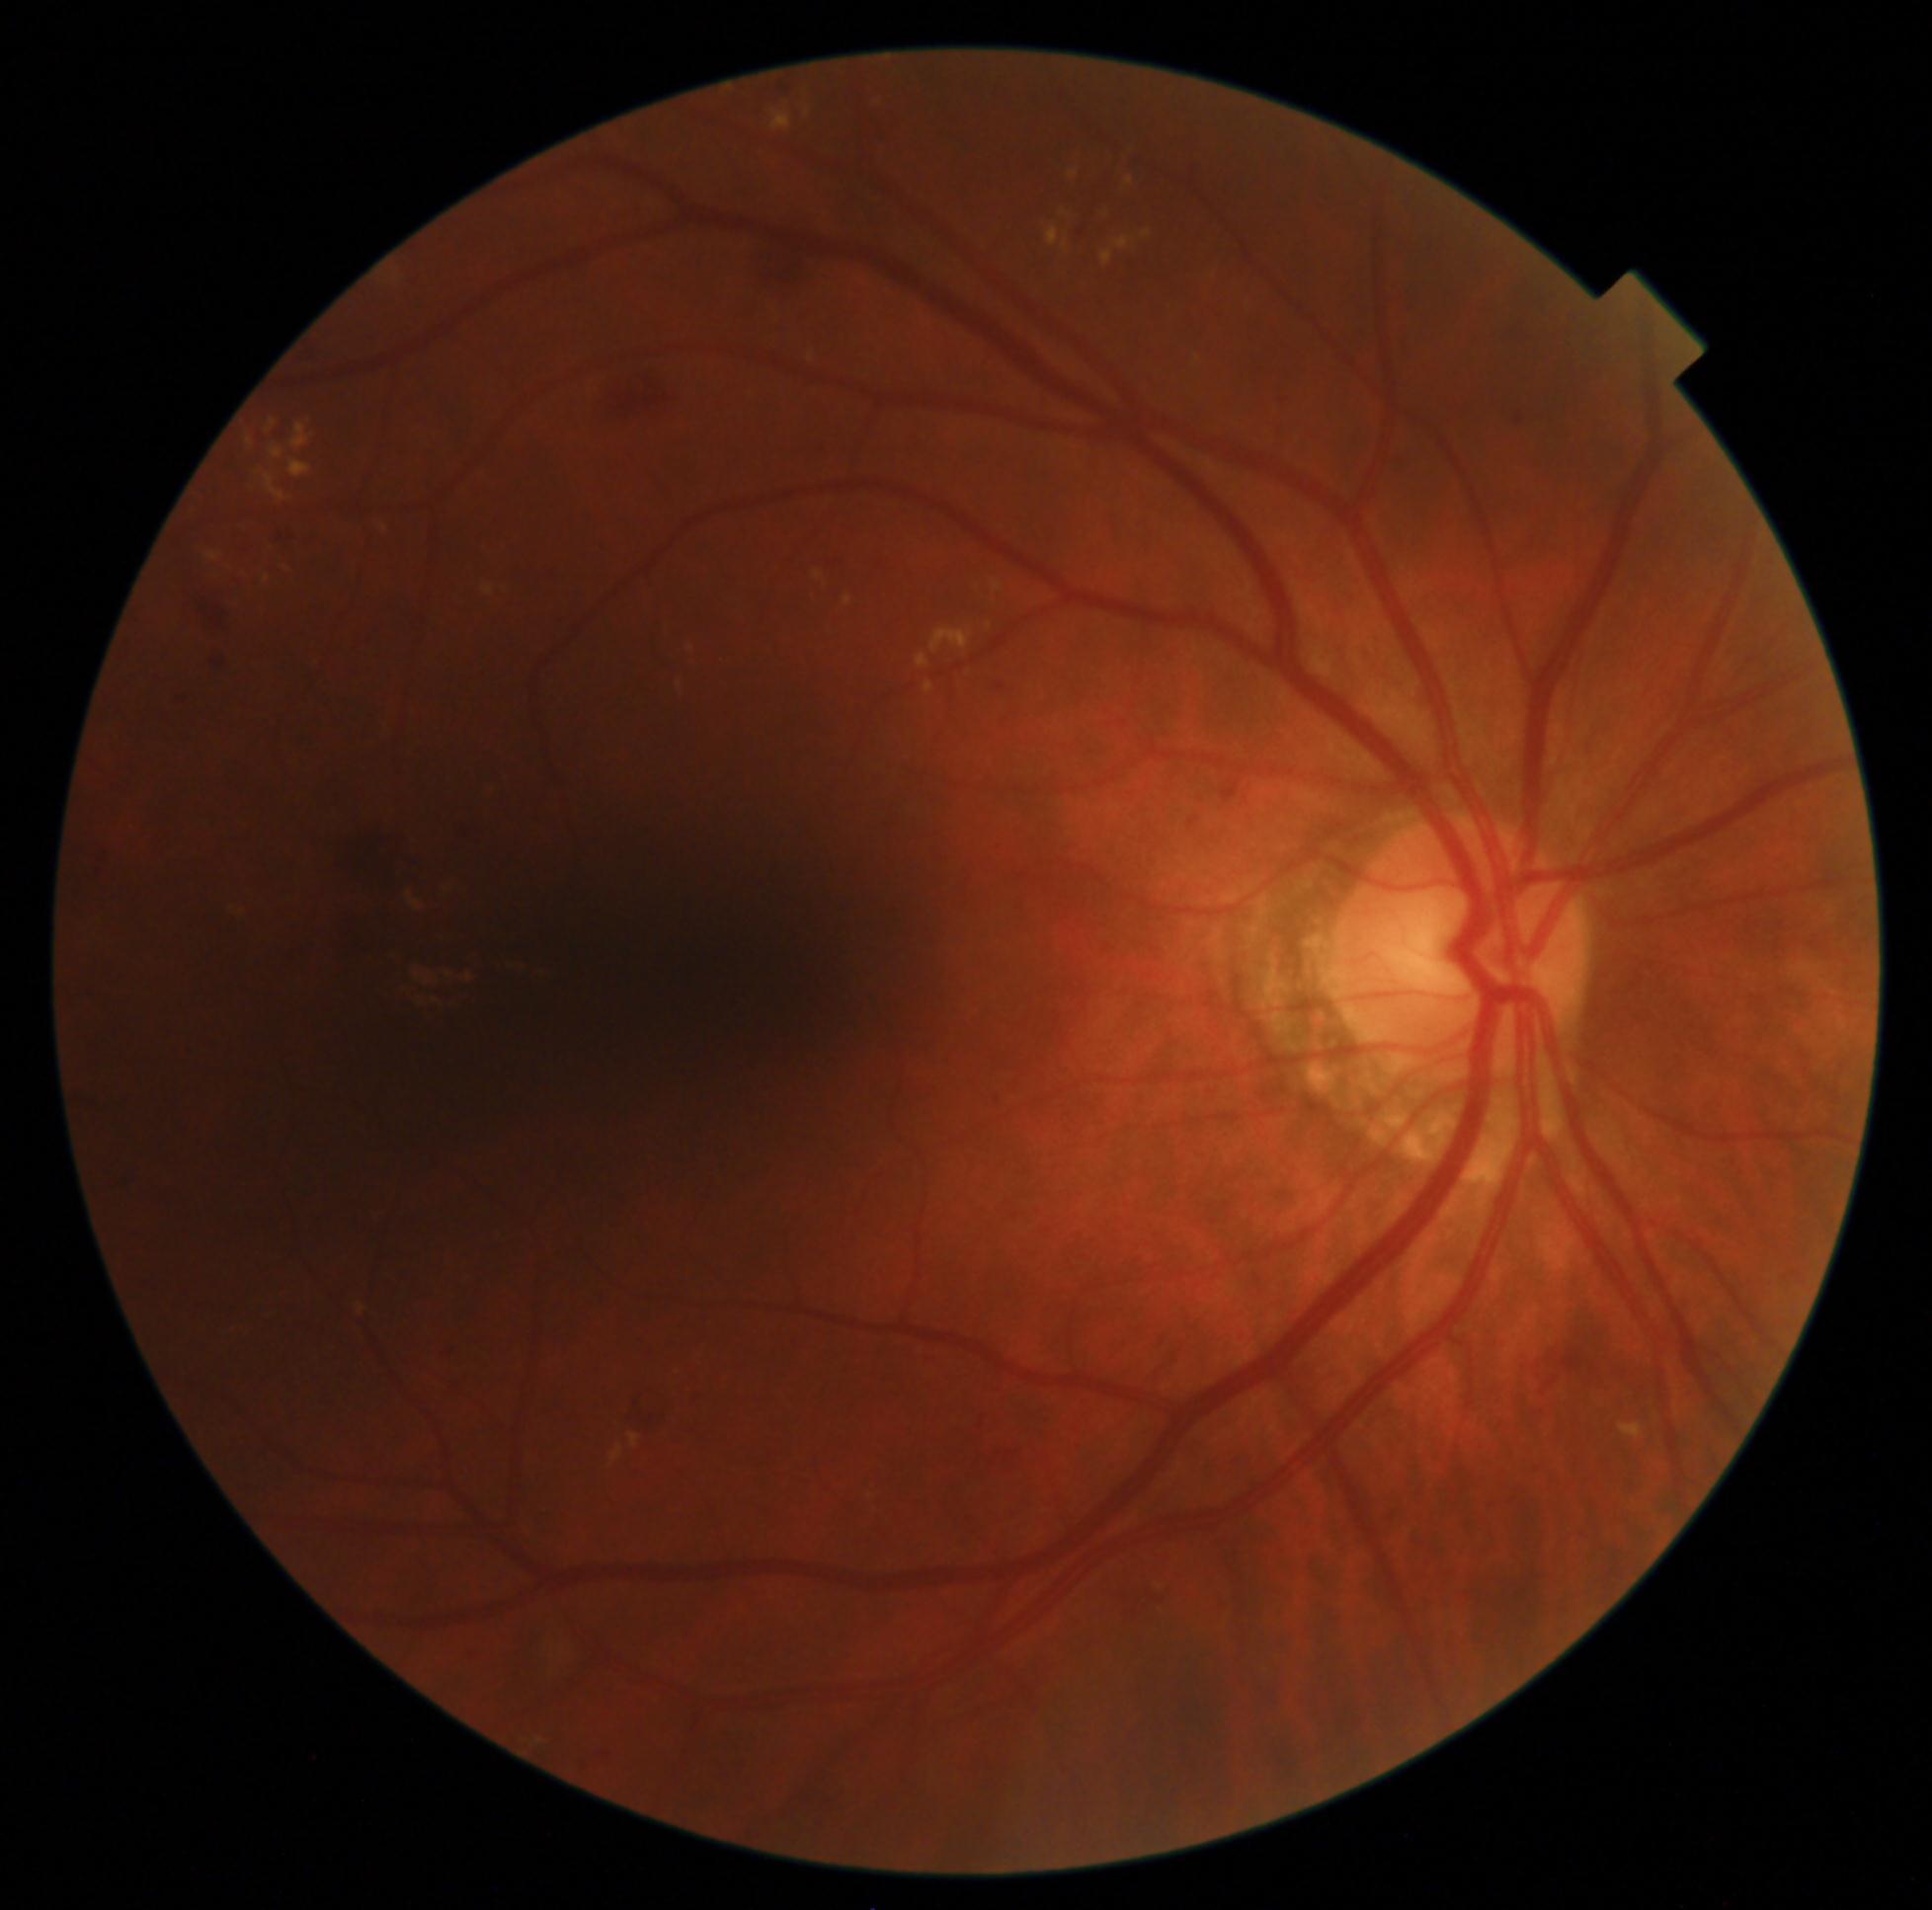

DR is 2/4.